Portable fundus photograph, 2212 by 1659 pixels — 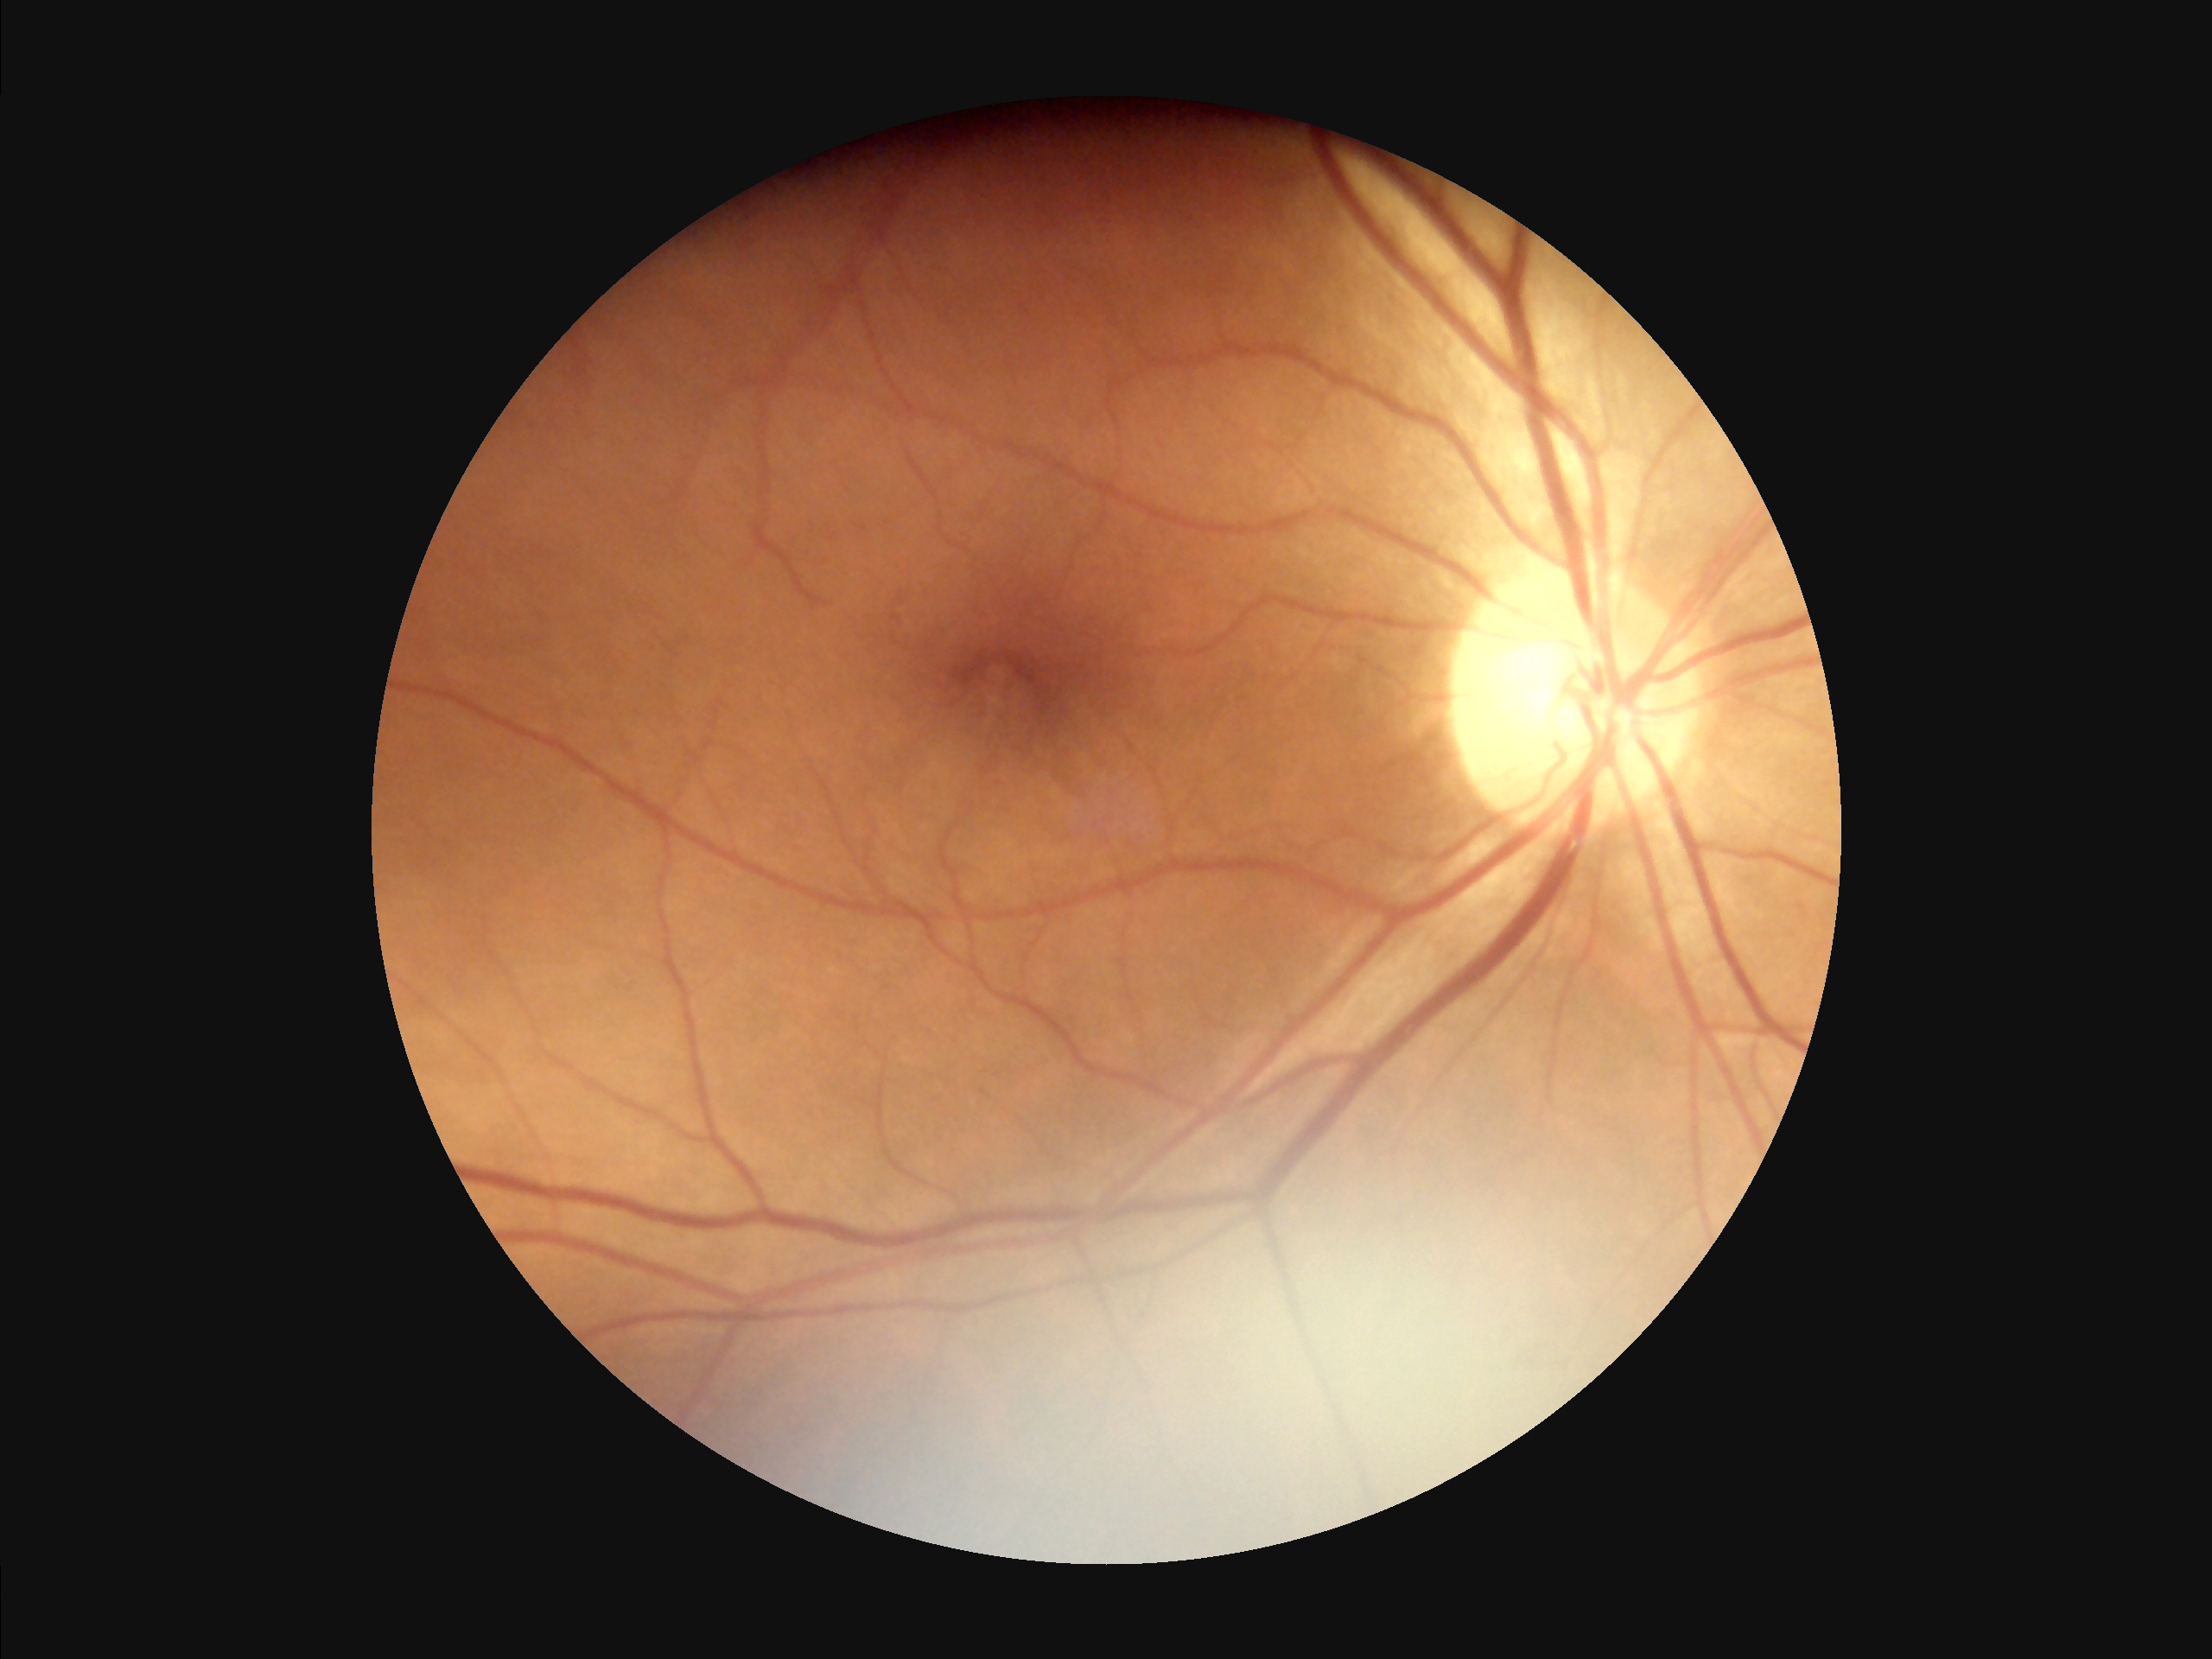

Image quality assessment: illumination: poor | clarity: good | overall: adequate.